45° FOV:
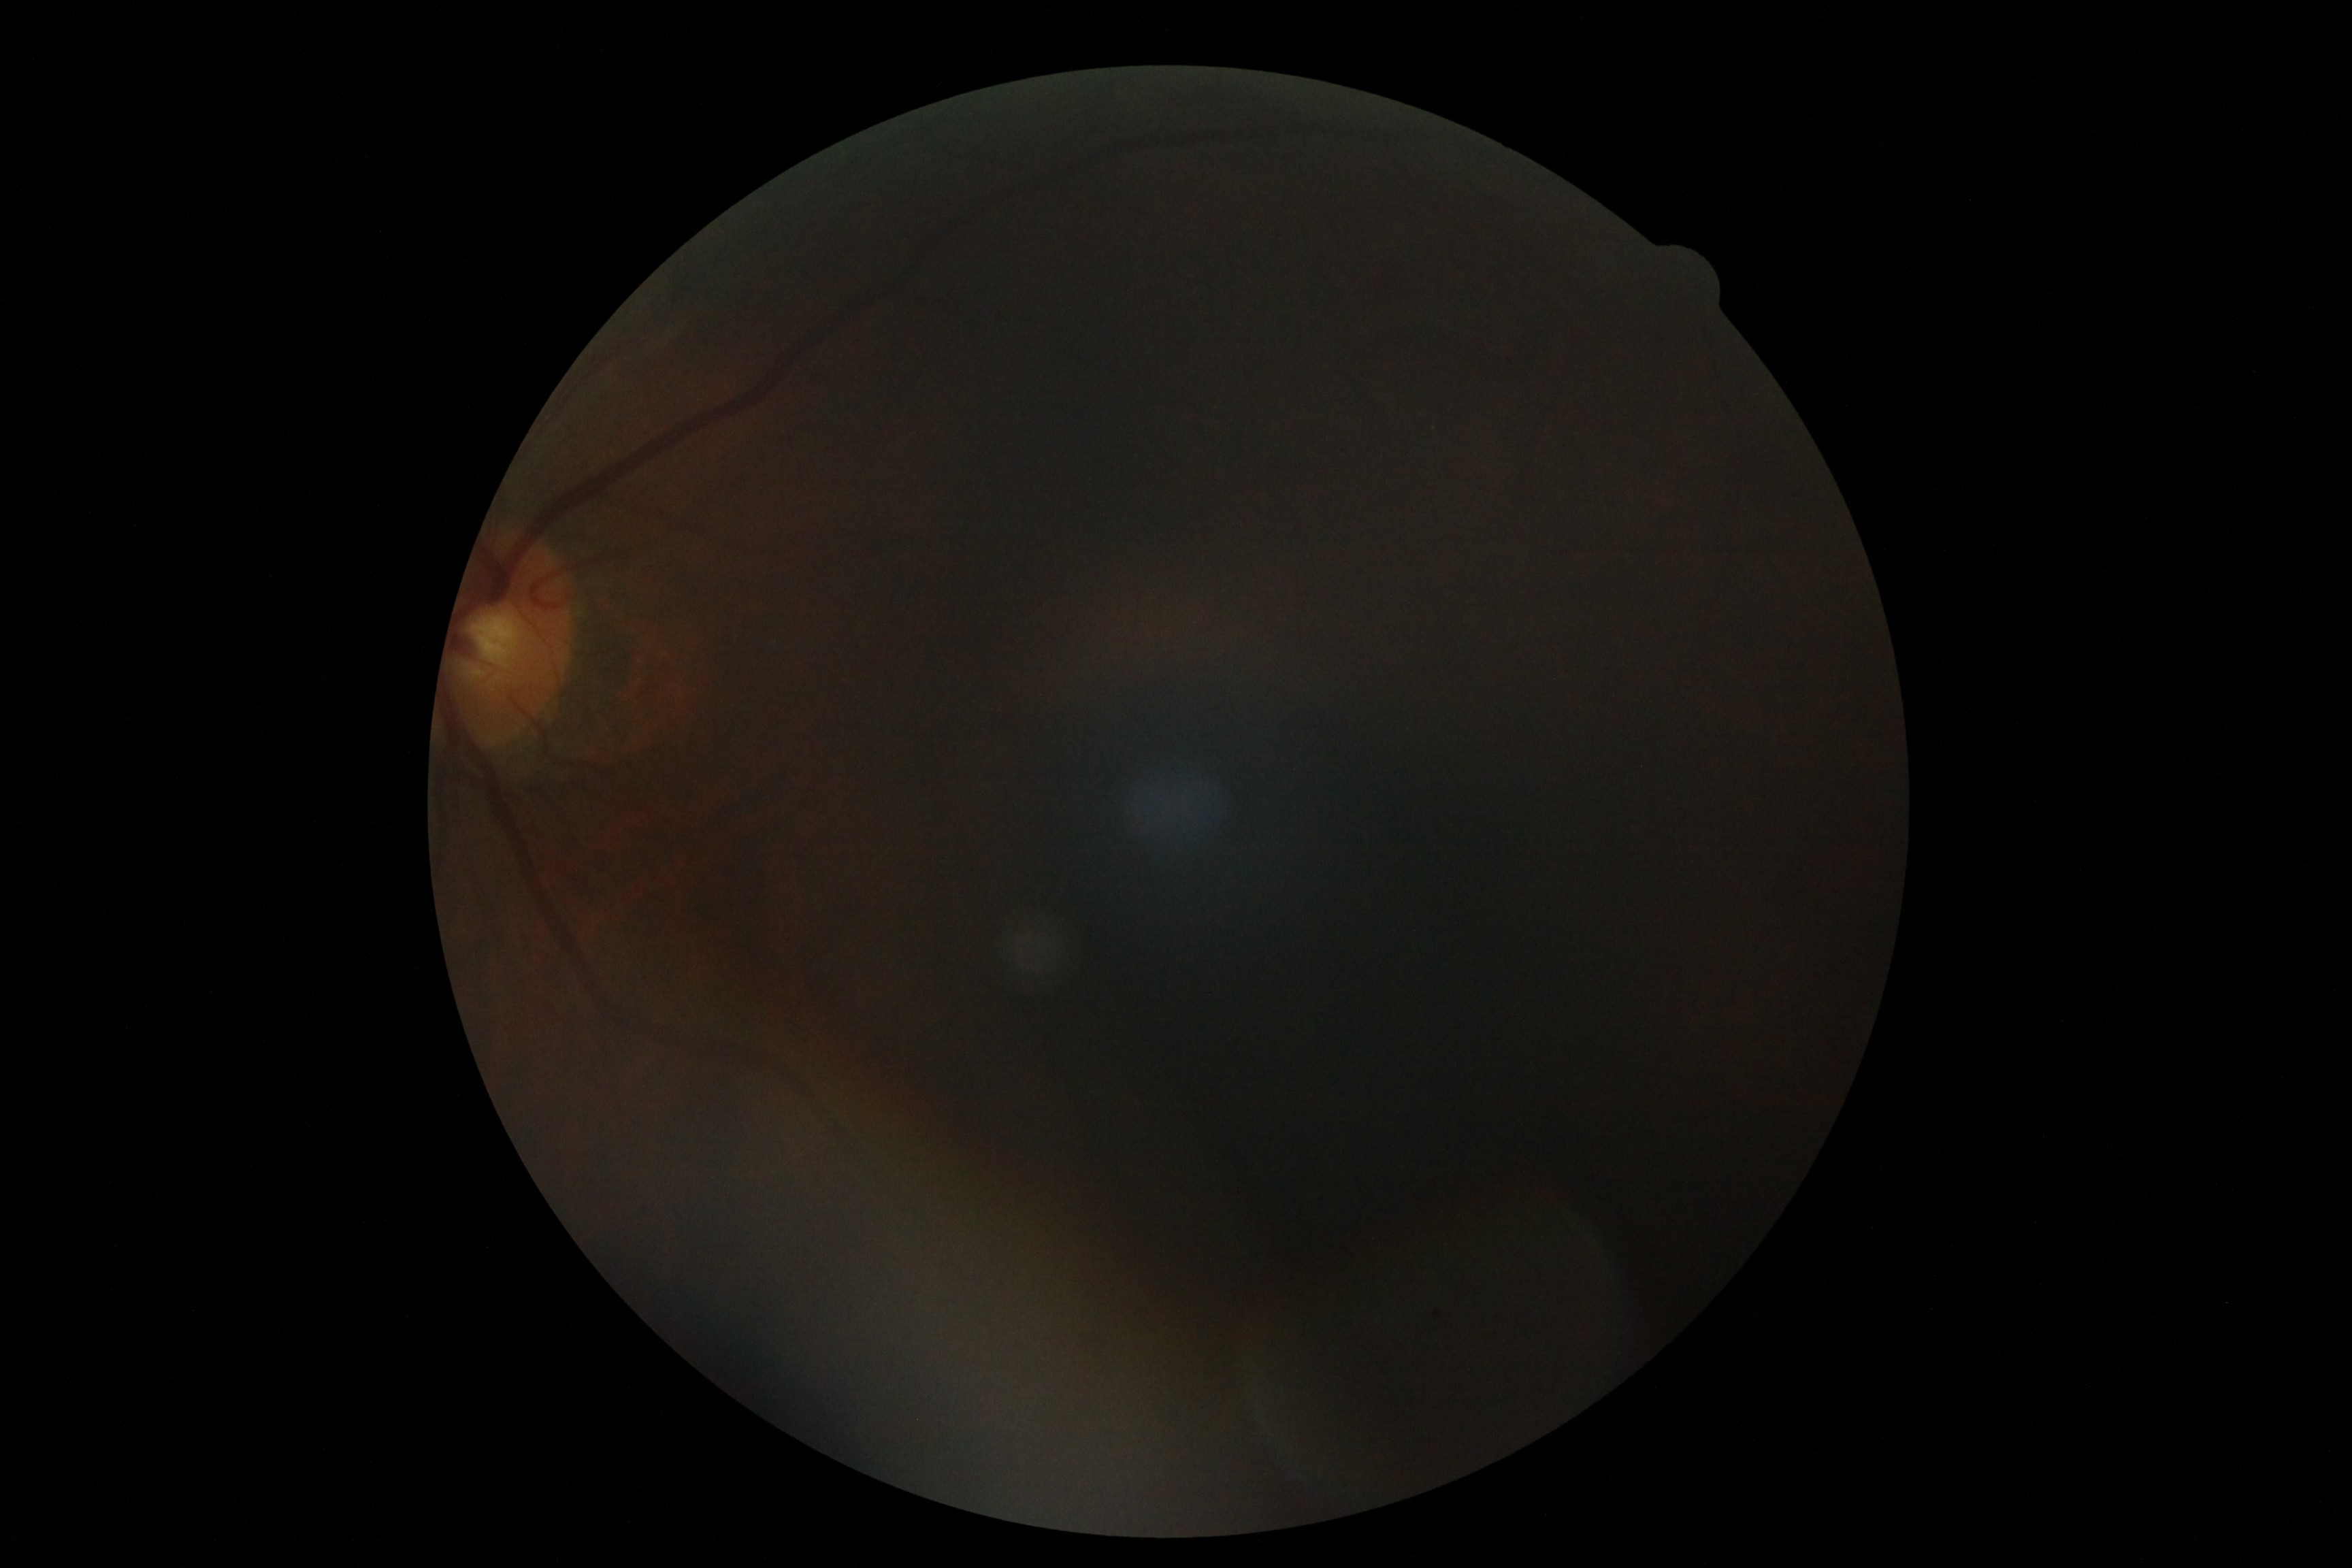

* diabetic retinopathy (DR): ungradable due to poor image quality